NIDEK AFC-230 fundus camera; 848 x 848 pixels; 45° field of view; diabetic retinopathy graded by the modified Davis classification
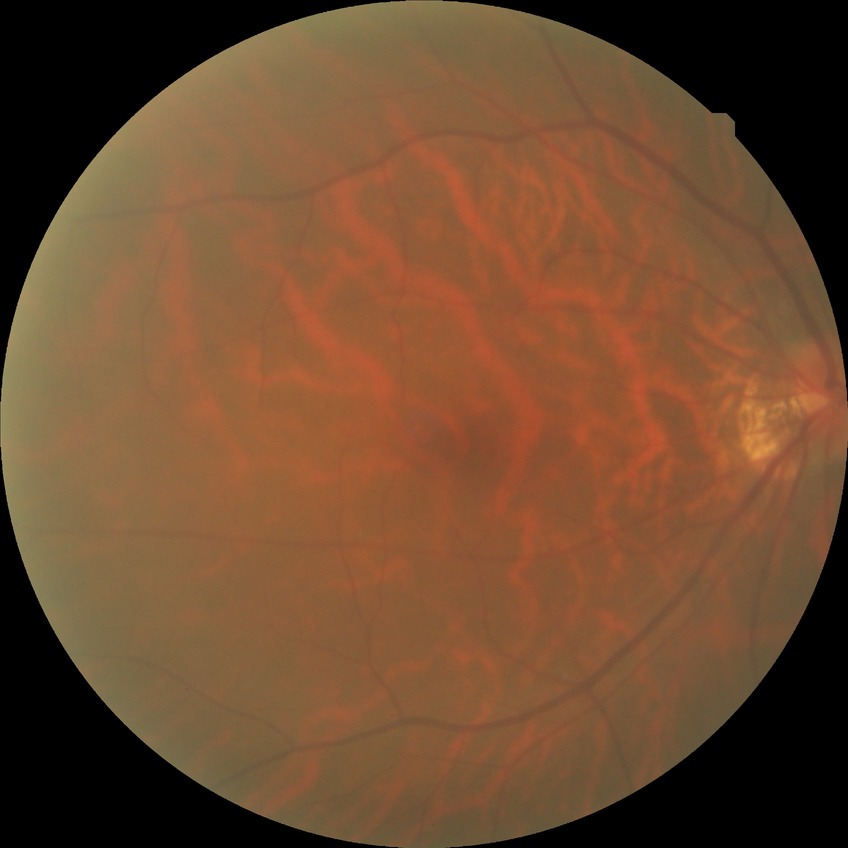   davis_grade: no diabetic retinopathy